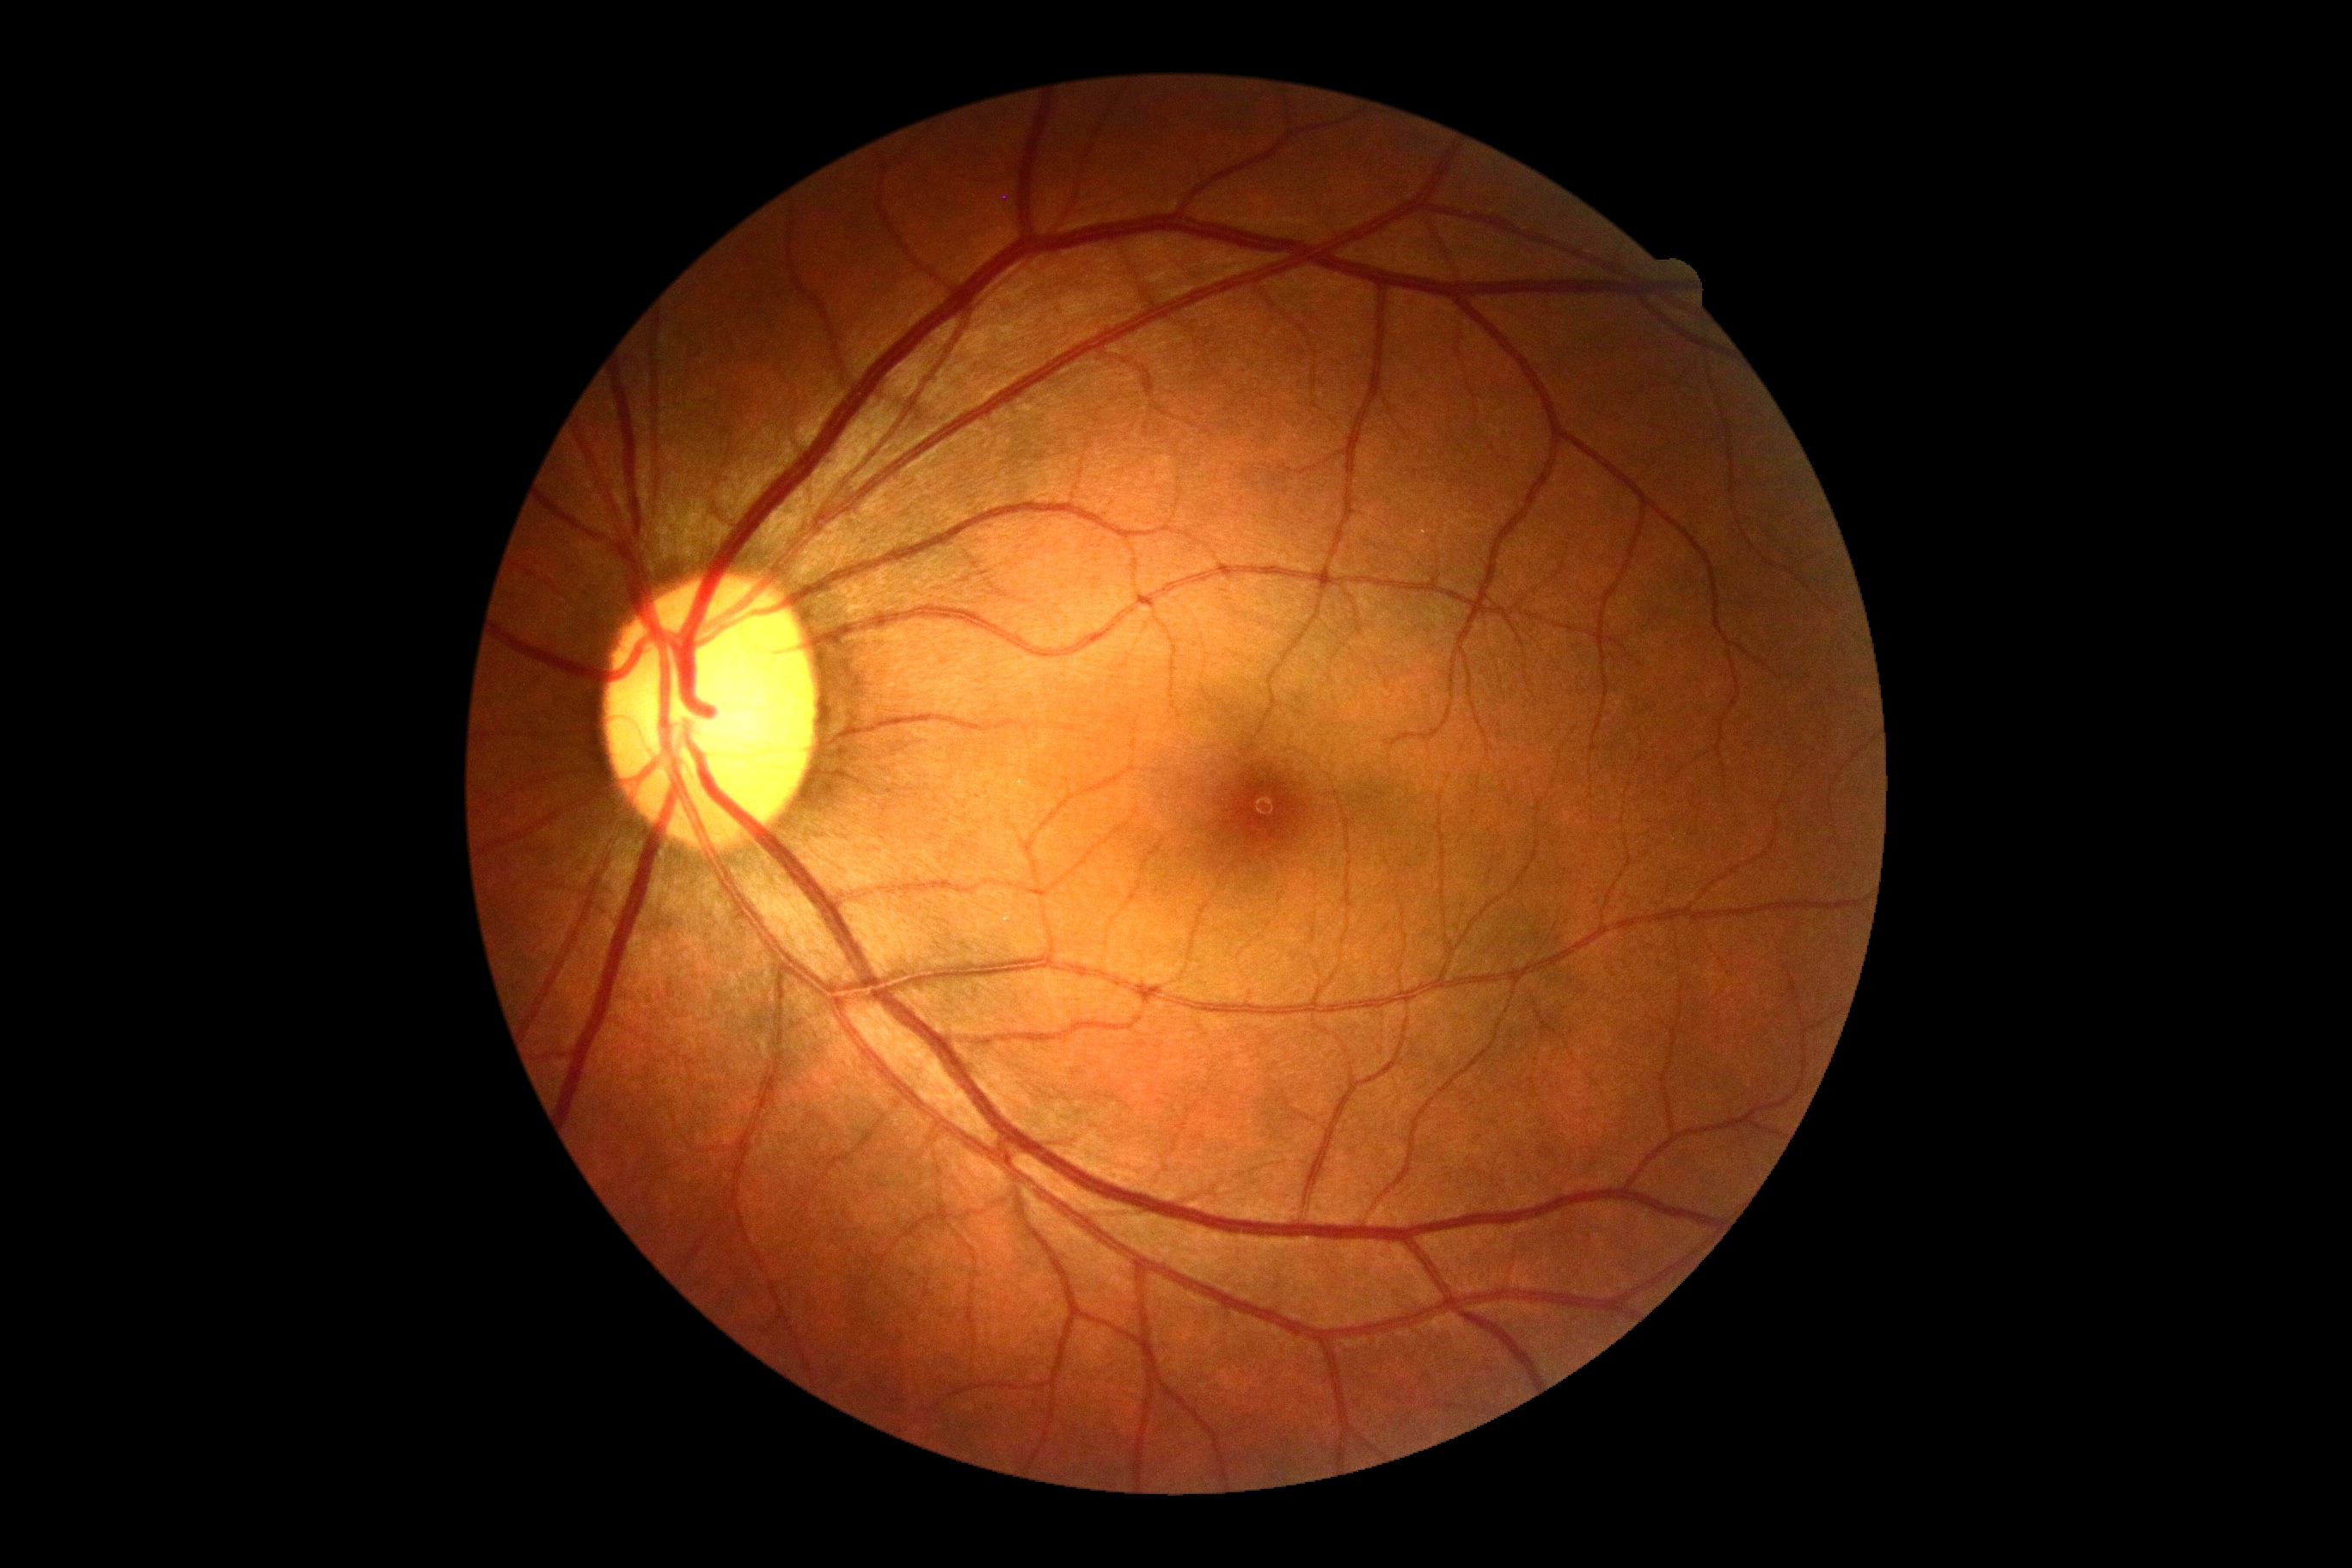
Diabetic retinopathy (DR): 0/4.